2228x1652px. Field includes the optic disc and macula. 50° FOV. Color fundus photograph. Captured after pupil dilation: 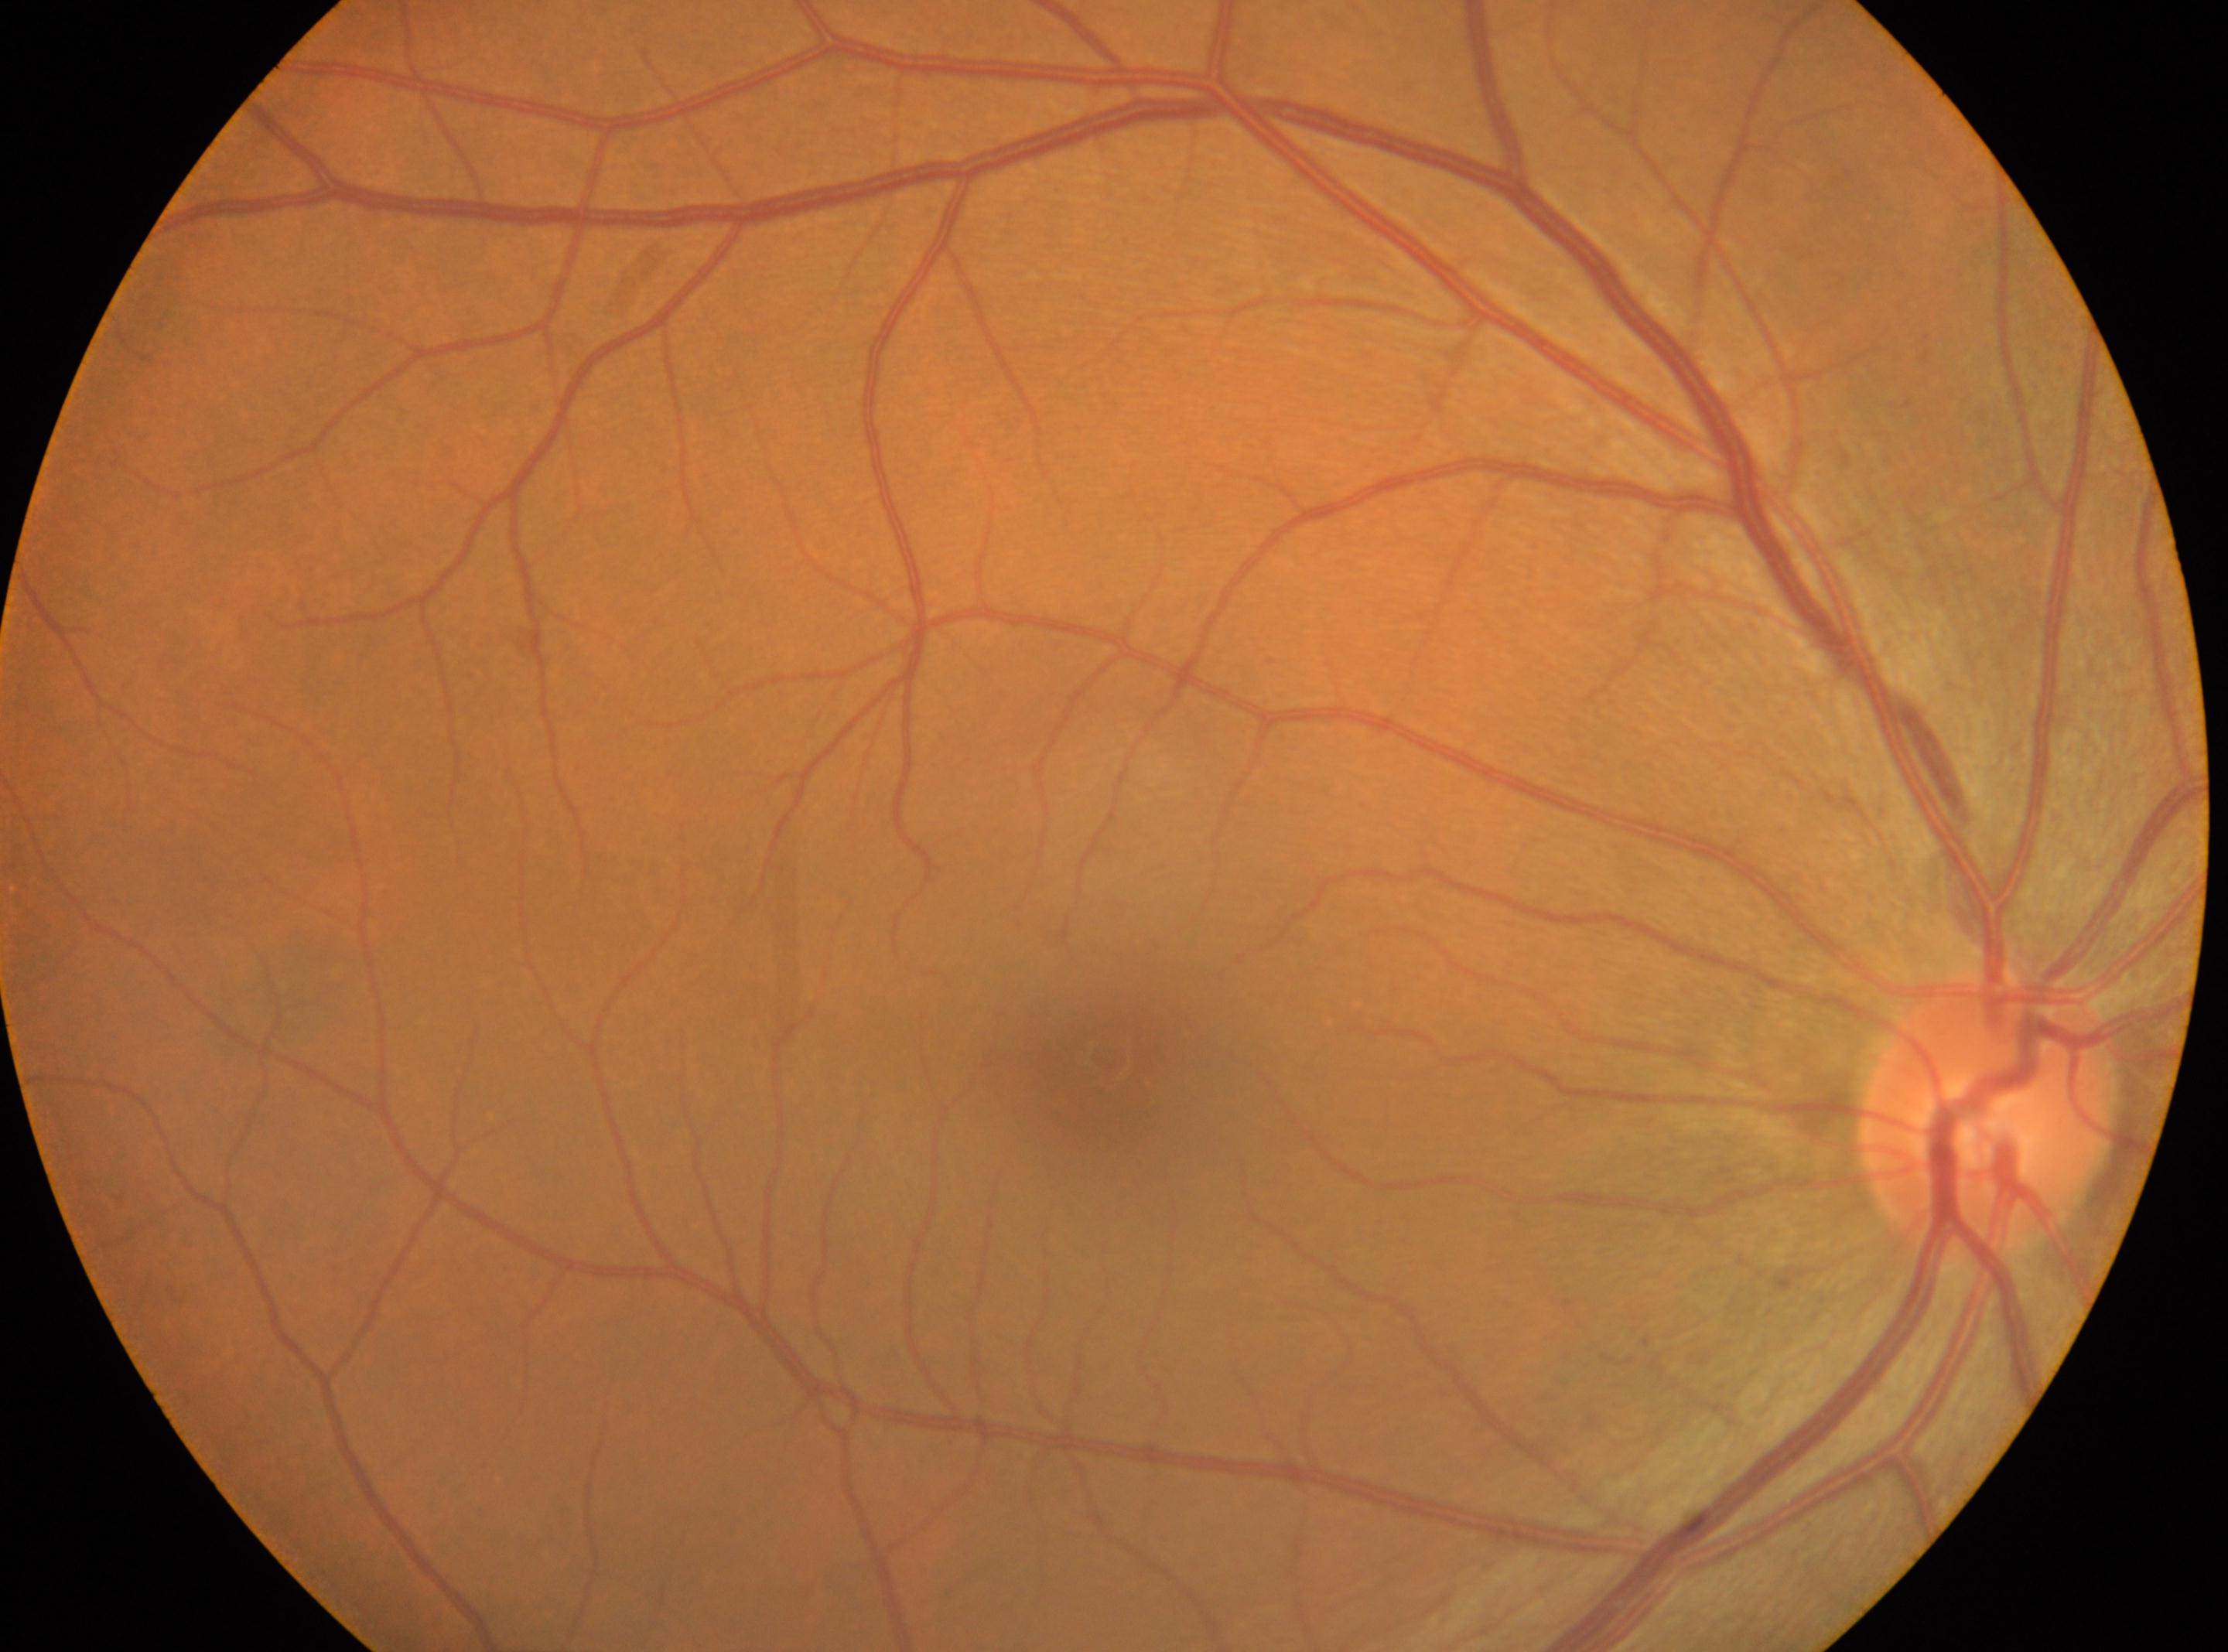

Retinopathy grade: 0.
No diabetic retinal disease findings.
This is the right eye.
The ONH is at [1990, 1111].
Macula center located at [1103, 1055].